45° FOV · CFP.
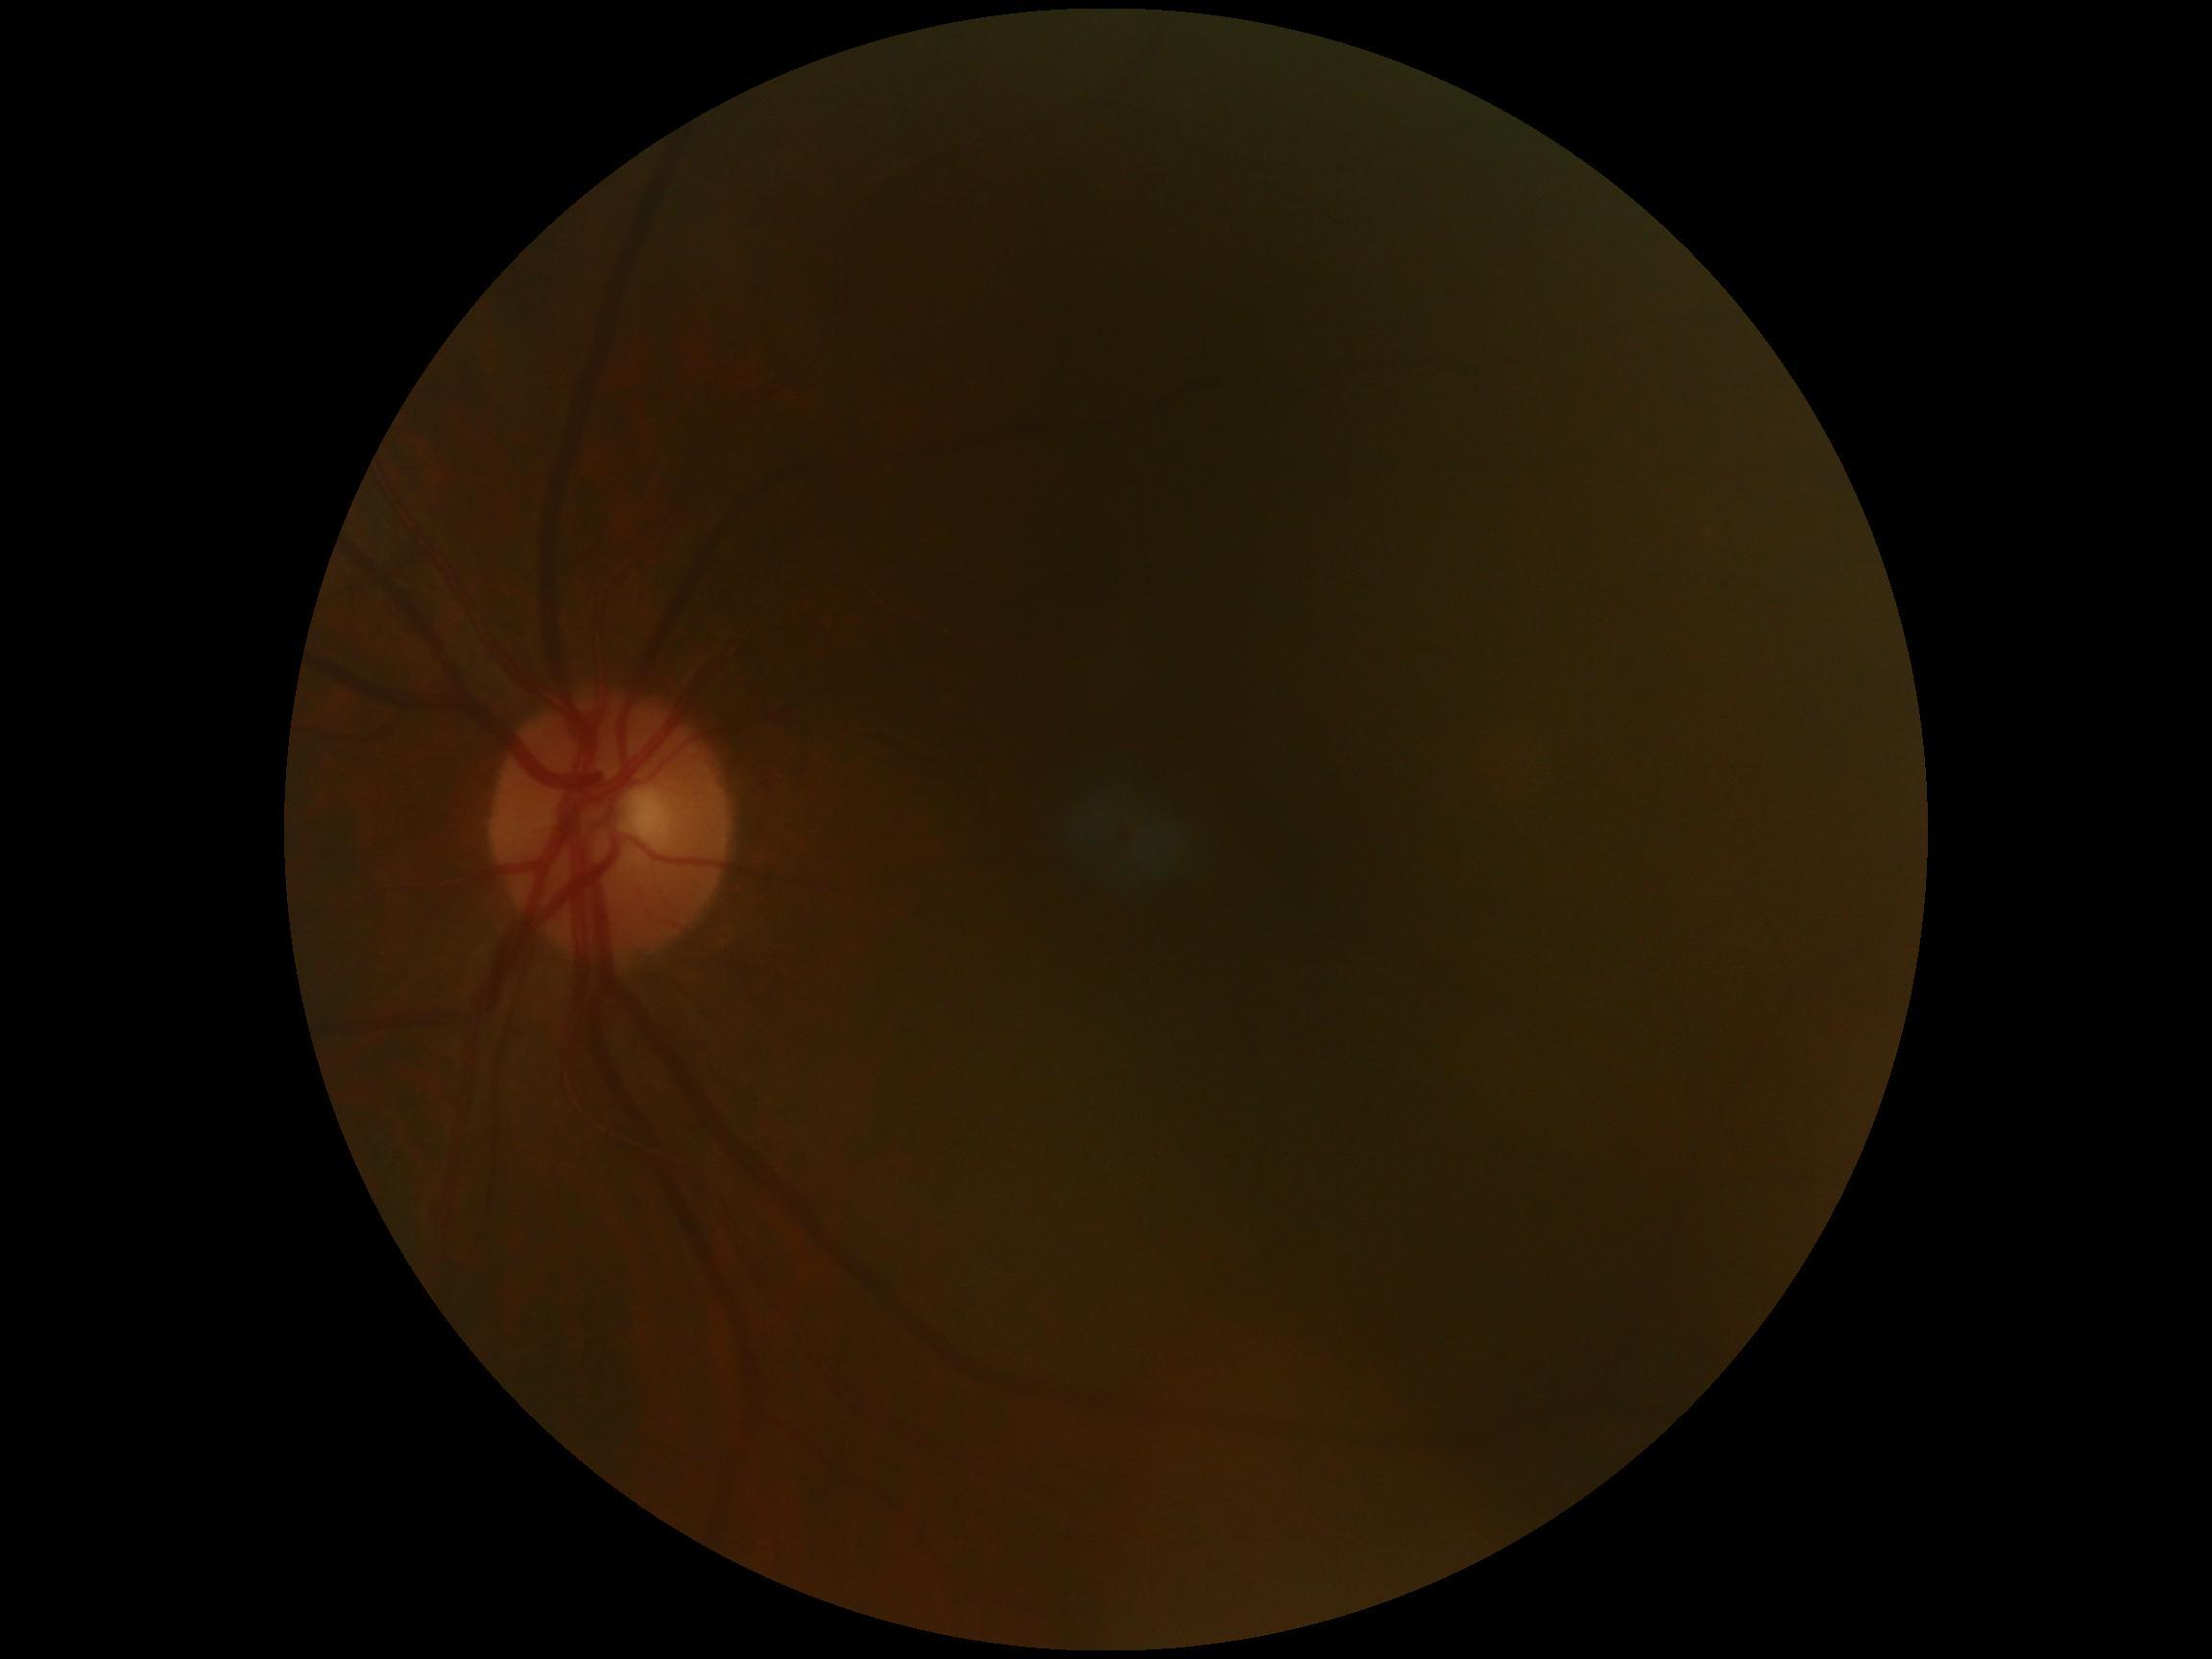
DR grade = 0 (no apparent retinopathy); DR impression = no signs of DR.